45° FOV — 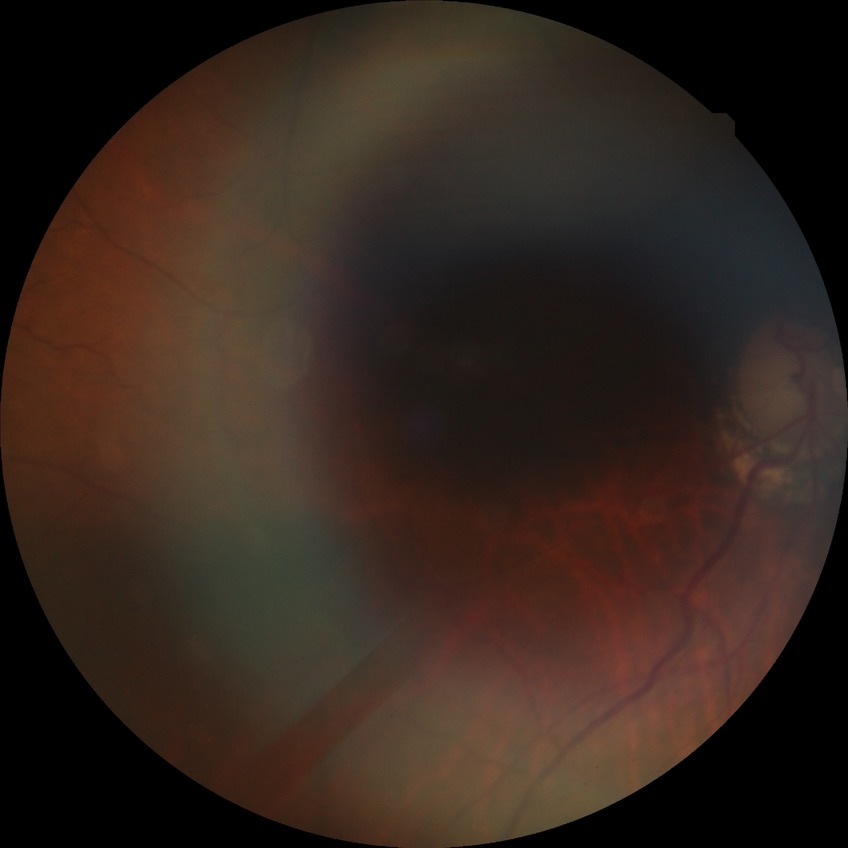
davis_grade: no diabetic retinopathy